2228 by 1652 pixels.
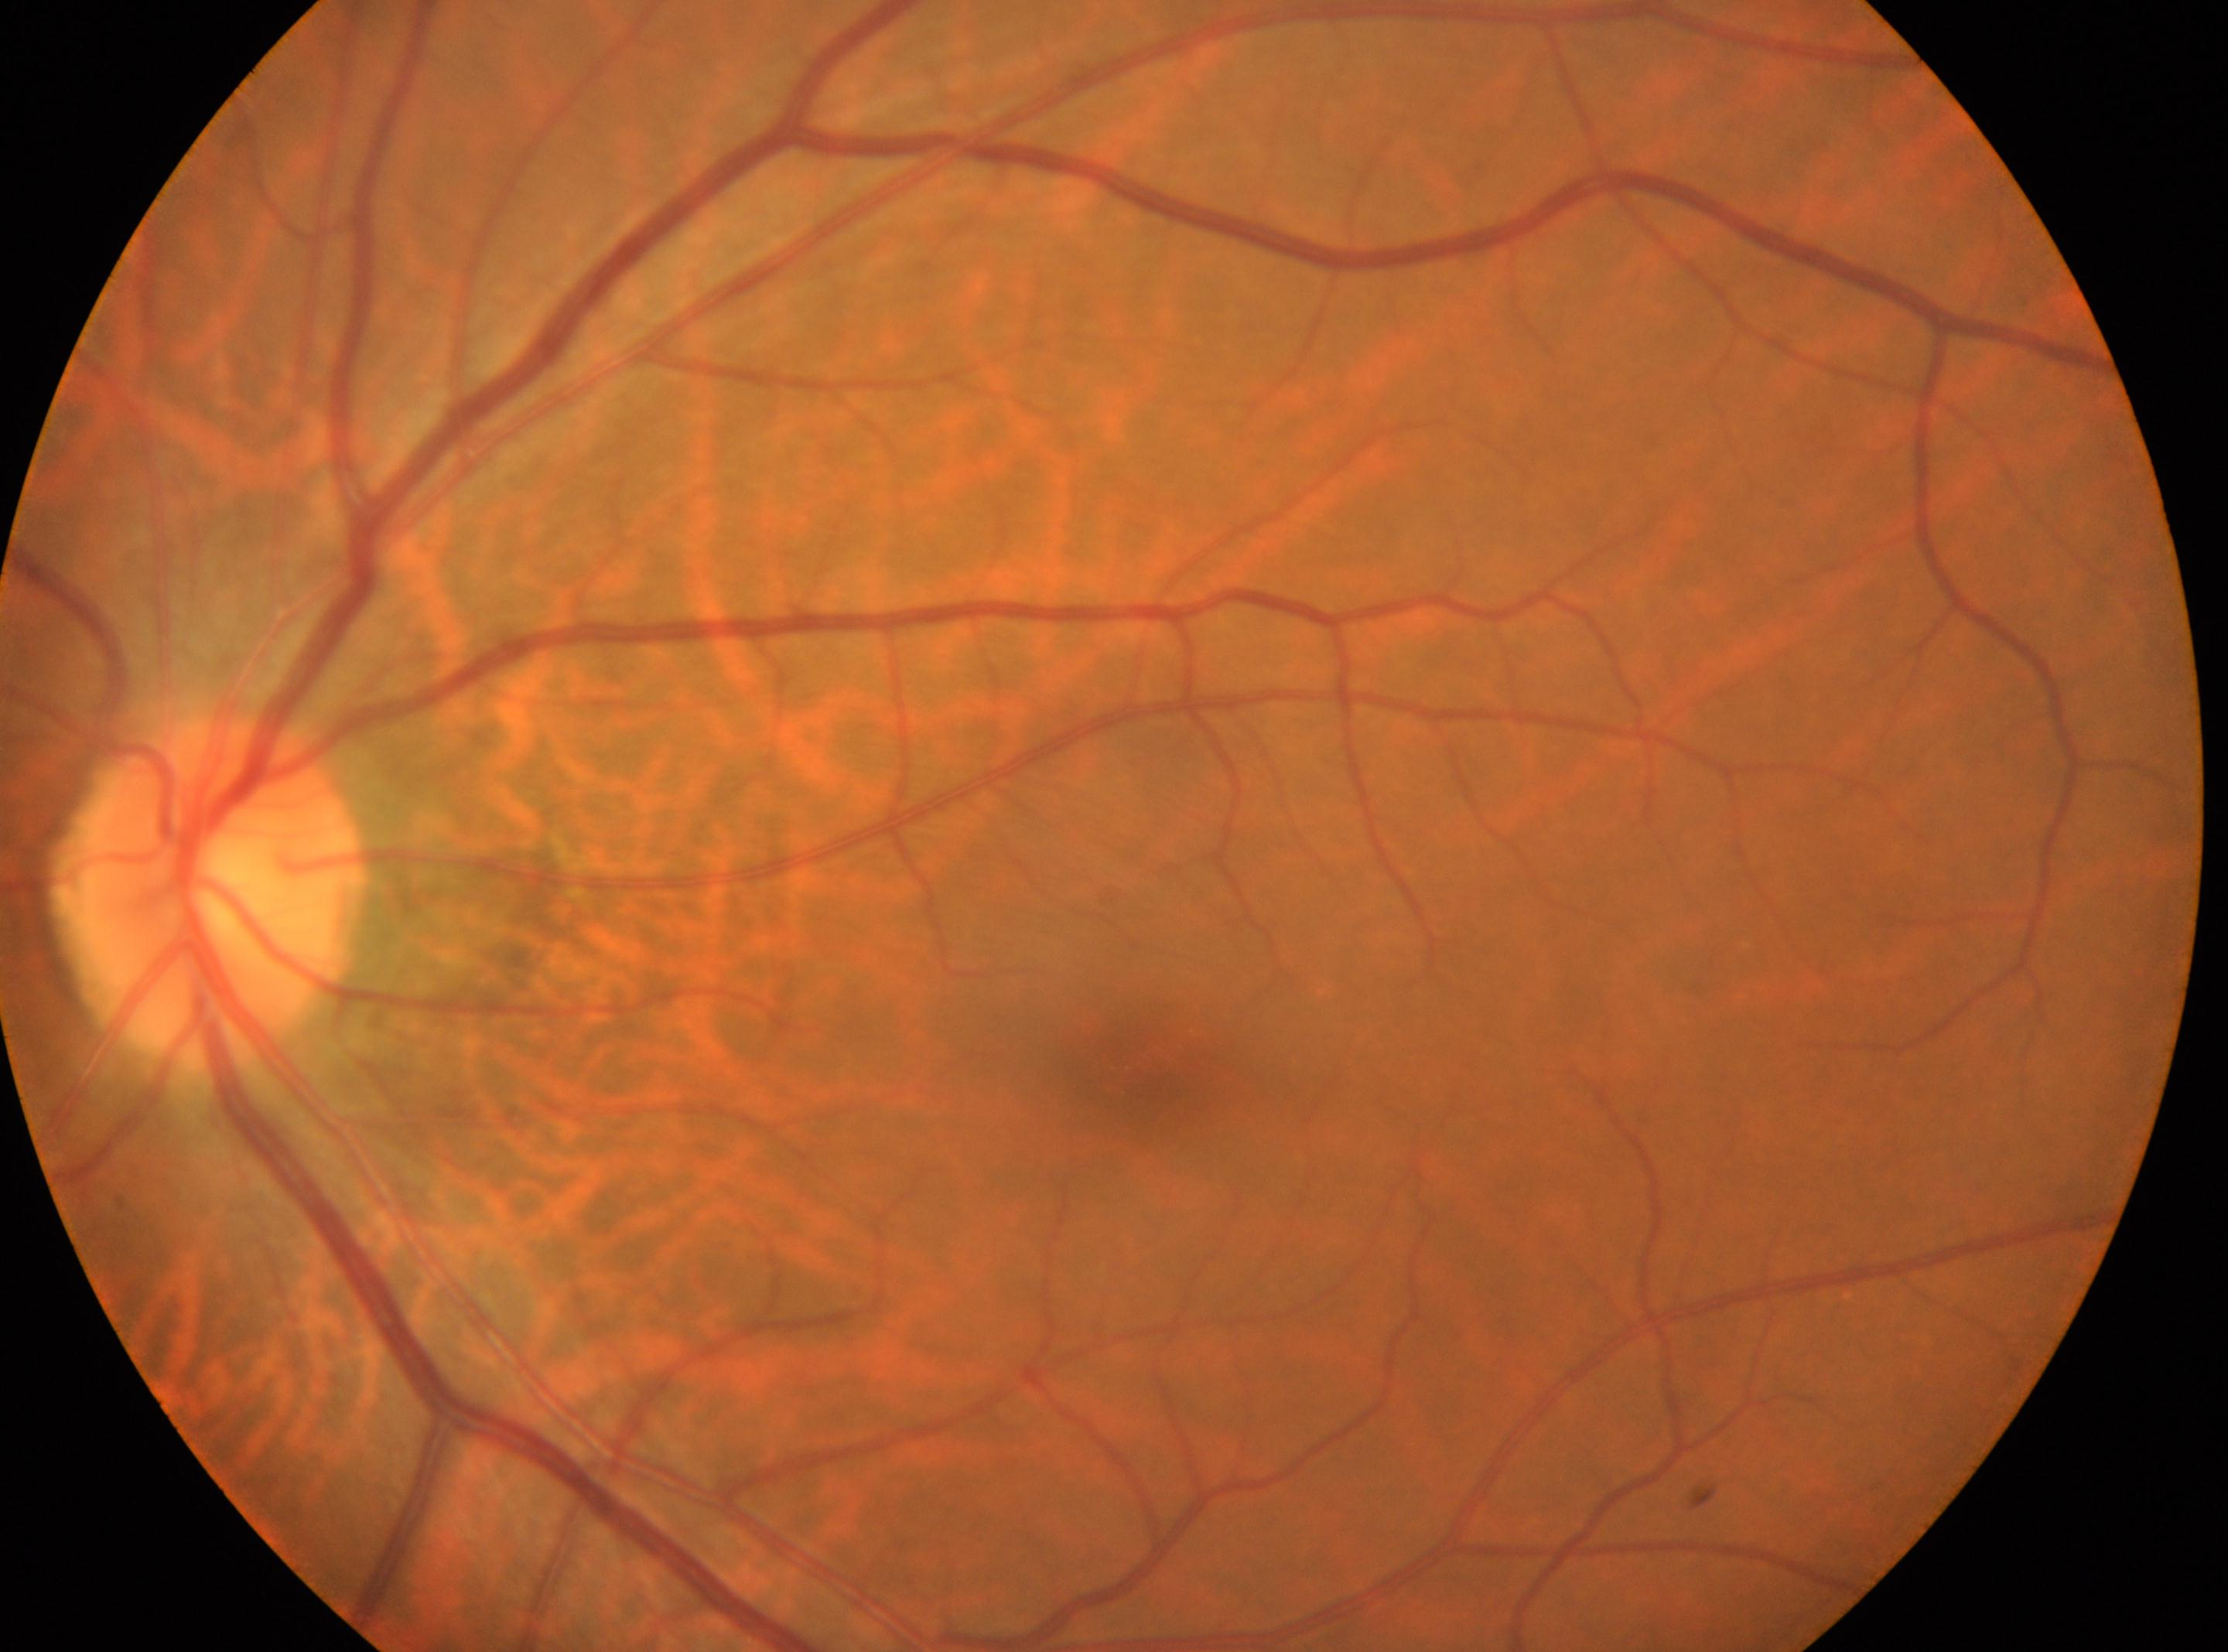
Eye: left.
The optic disc is at (206, 896).
The fovea is at (1150, 1053).
No diabetic retinal disease findings.
Retinopathy grade is no apparent retinopathy (0).